Modified Davis classification
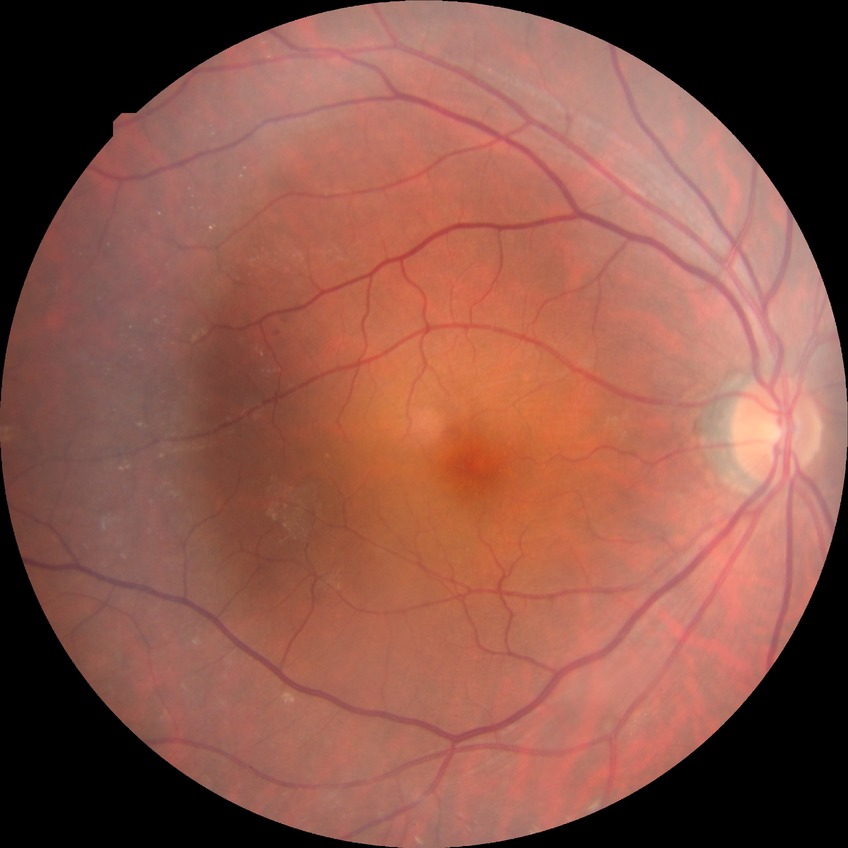
– diabetic retinopathy grade — simple diabetic retinopathy